Fundus photo — 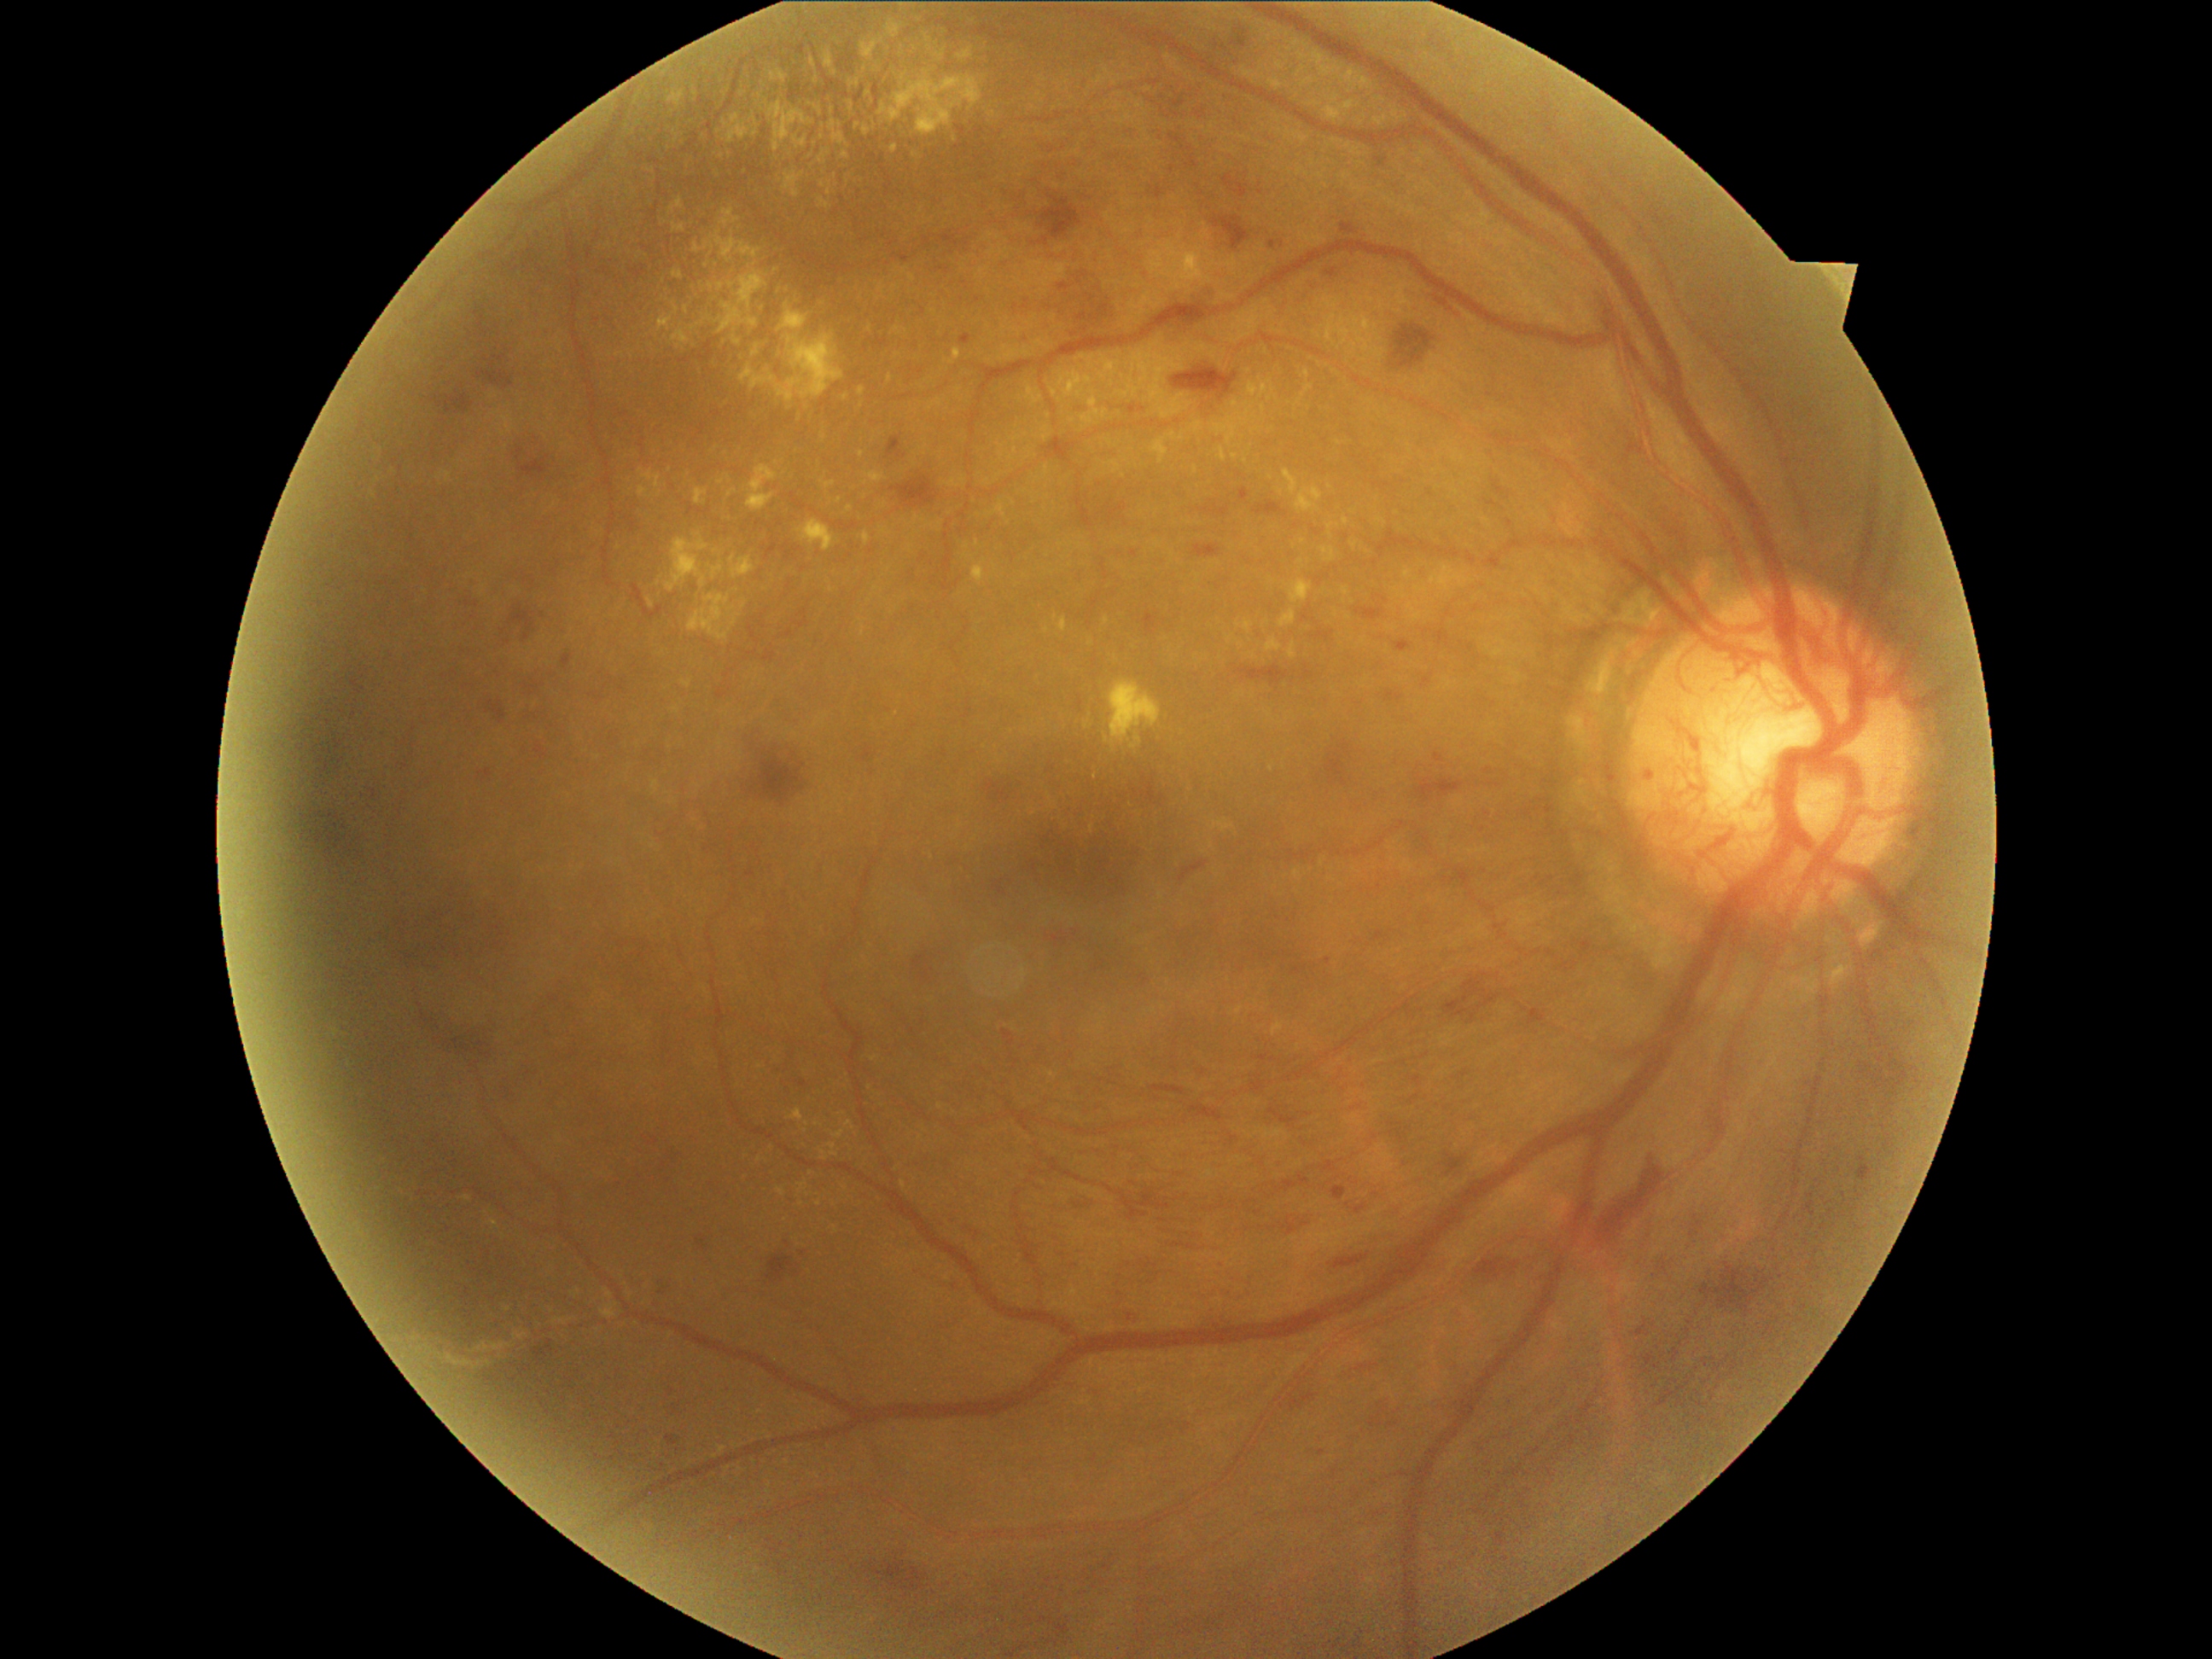 Retinopathy grade: 4/4.
Hemorrhages are present, including at Rect(1172, 100, 1185, 108) | Rect(1151, 1085, 1185, 1097) | Rect(475, 370, 515, 390) | Rect(335, 861, 344, 868) | Rect(1035, 190, 1083, 247) | Rect(1385, 692, 1404, 702) | Rect(1254, 501, 1284, 516) | Rect(1493, 480, 1508, 499) | Rect(1189, 1105, 1223, 1122) | Rect(1701, 1262, 1774, 1317) | Rect(1447, 1155, 1465, 1173) | Rect(433, 390, 474, 416) | Rect(1213, 216, 1250, 252) | Rect(352, 680, 363, 696) | Rect(1392, 325, 1436, 370).
Small hemorrhages approximately at 301/807 | 304/760.
Hard exudates are present, including at Rect(1269, 79, 1284, 91) | Rect(515, 1332, 528, 1339) | Rect(1289, 643, 1298, 660) | Rect(863, 38, 885, 61) | Rect(672, 330, 690, 344) | Rect(1252, 428, 1262, 434) | Rect(718, 271, 769, 335) | Rect(890, 44, 919, 71) | Rect(859, 388, 866, 397) | Rect(1245, 404, 1254, 409) | Rect(1201, 248, 1213, 276) | Rect(489, 1220, 499, 1230) | Rect(829, 120, 835, 132) | Rect(670, 199, 684, 214).
Small hard exudates approximately at 806/1131 | 914/156 | 1235/457 | 912/279 | 732/609 | 832/591.